DR severity per modified Davis staging
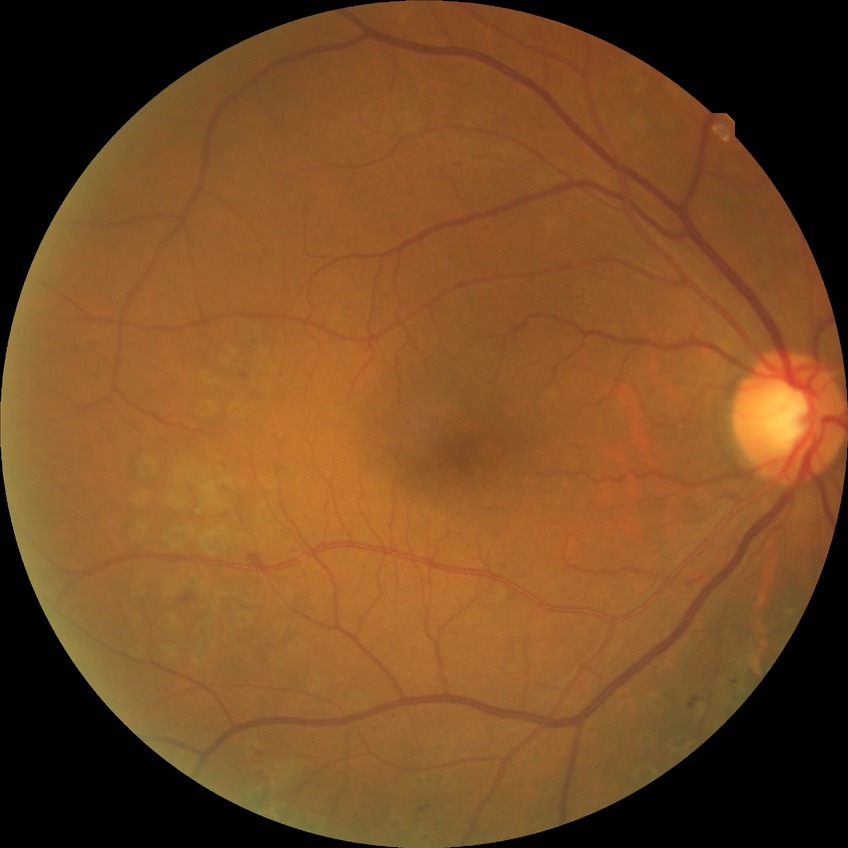 Modified Davis grading is proliferative diabetic retinopathy.